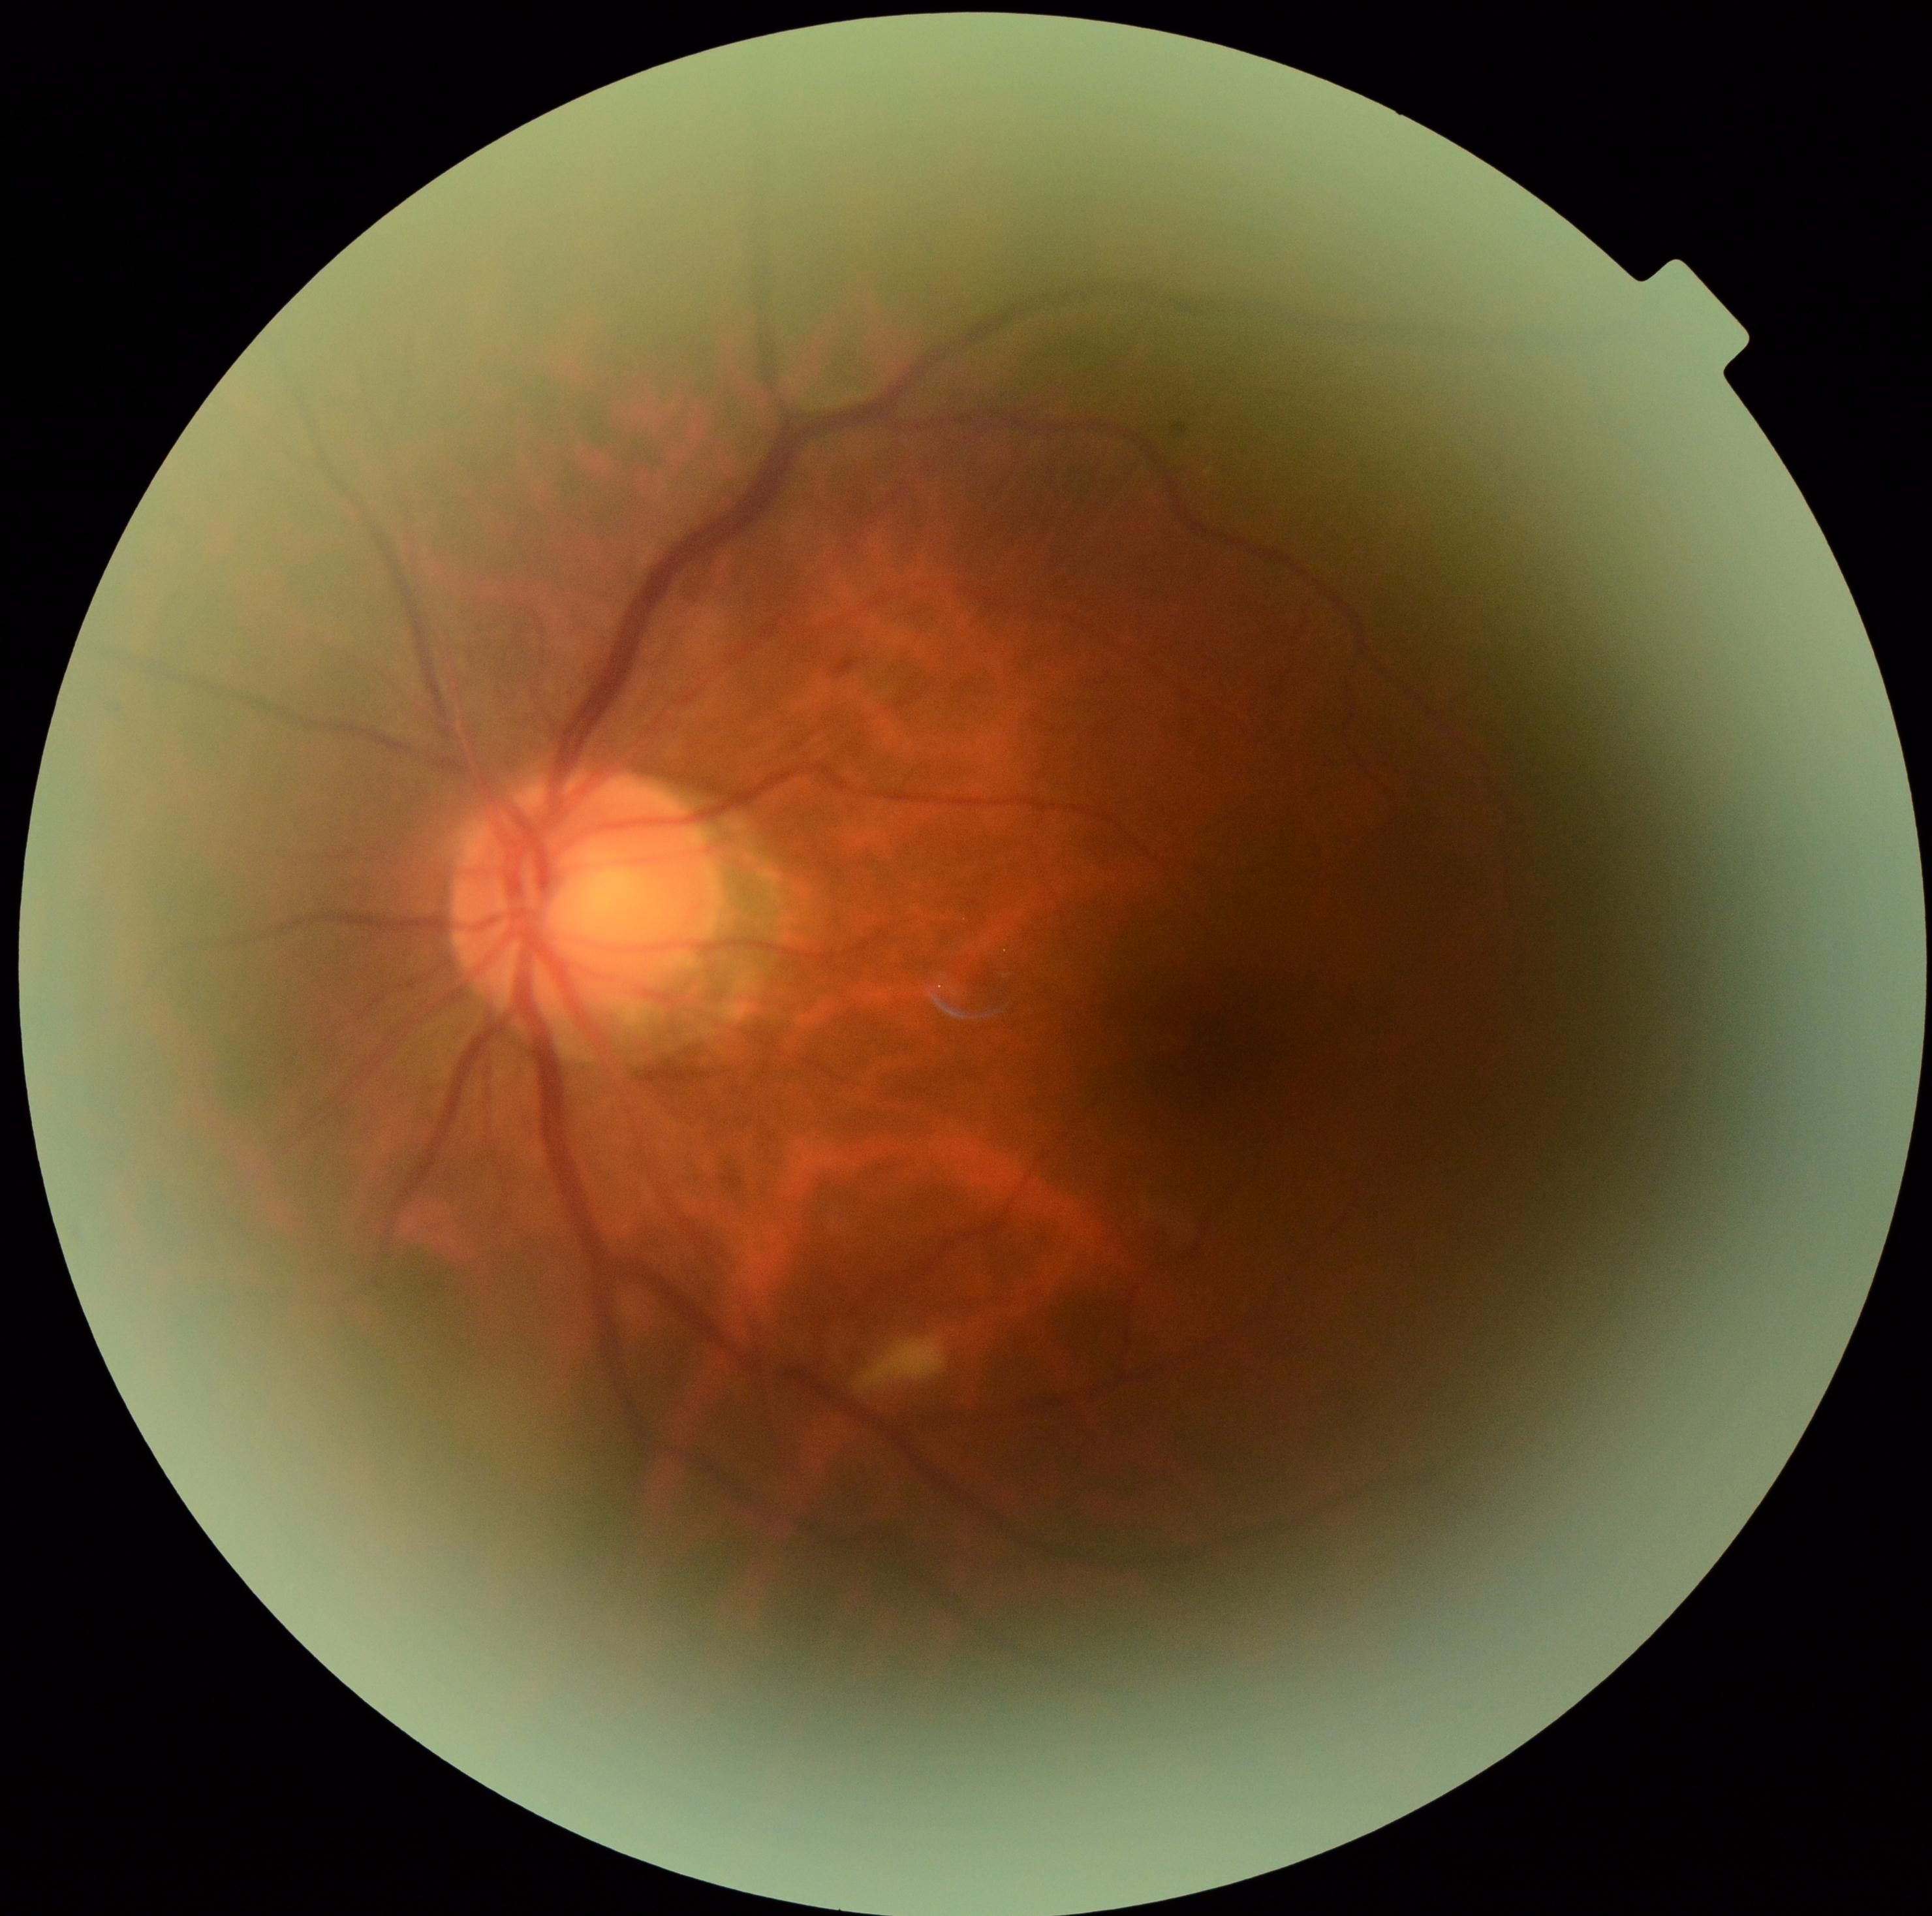
diabetic retinopathy (DR)=2.